Infant wide-field retinal image: 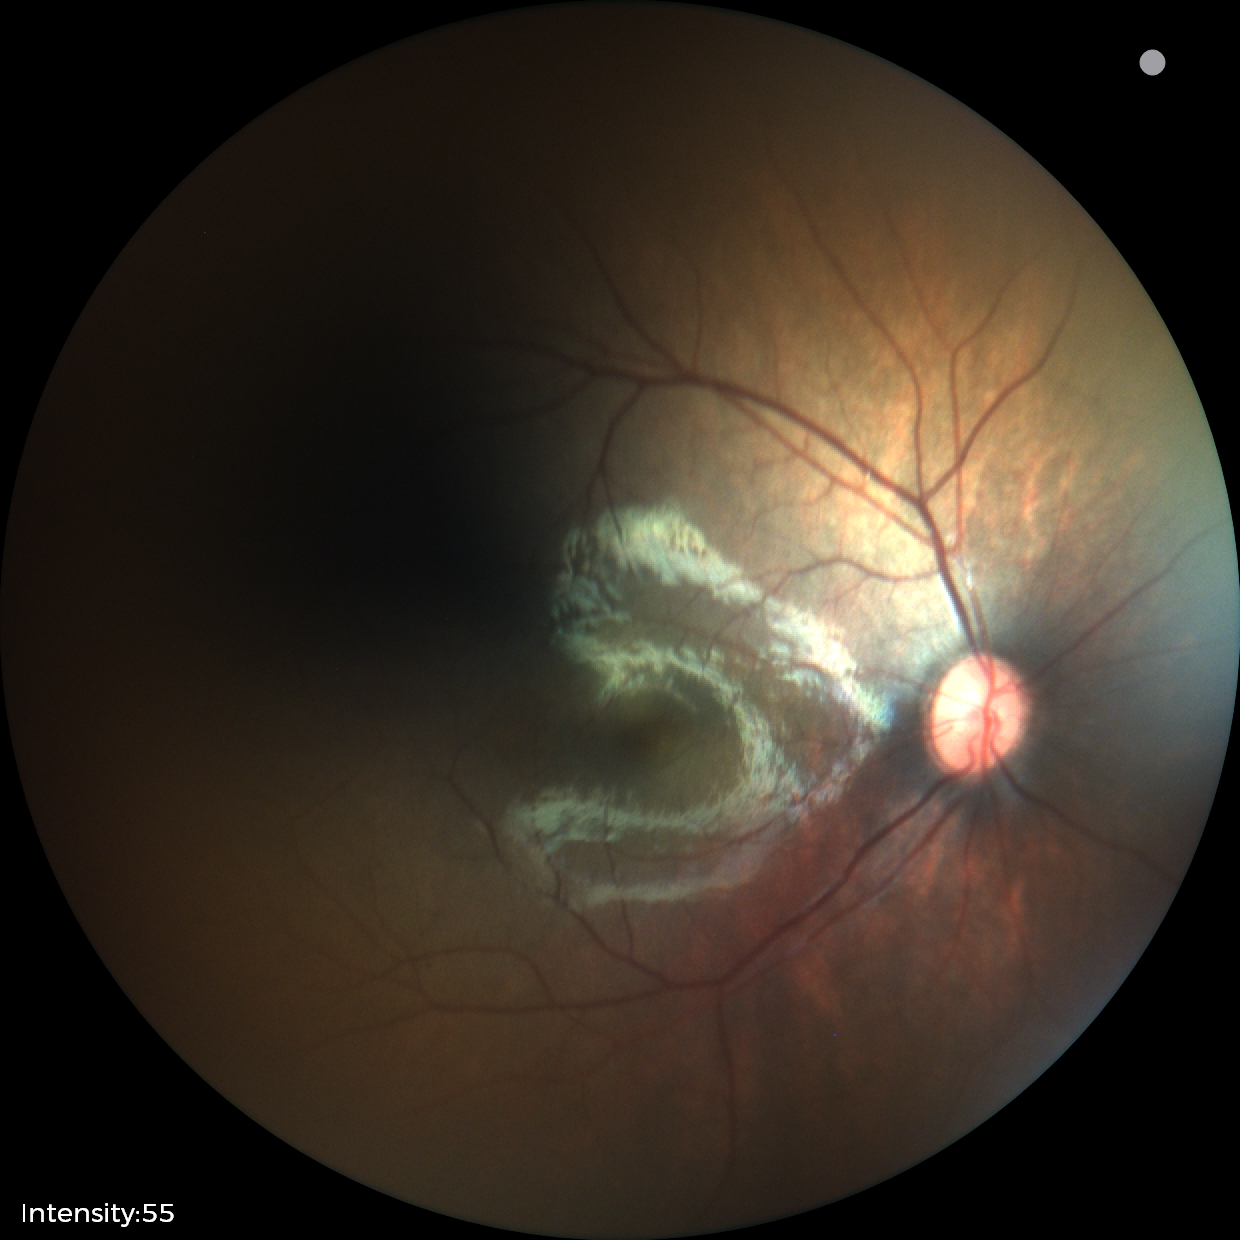

Screening diagnosis: physiological appearance with no retinal pathology.